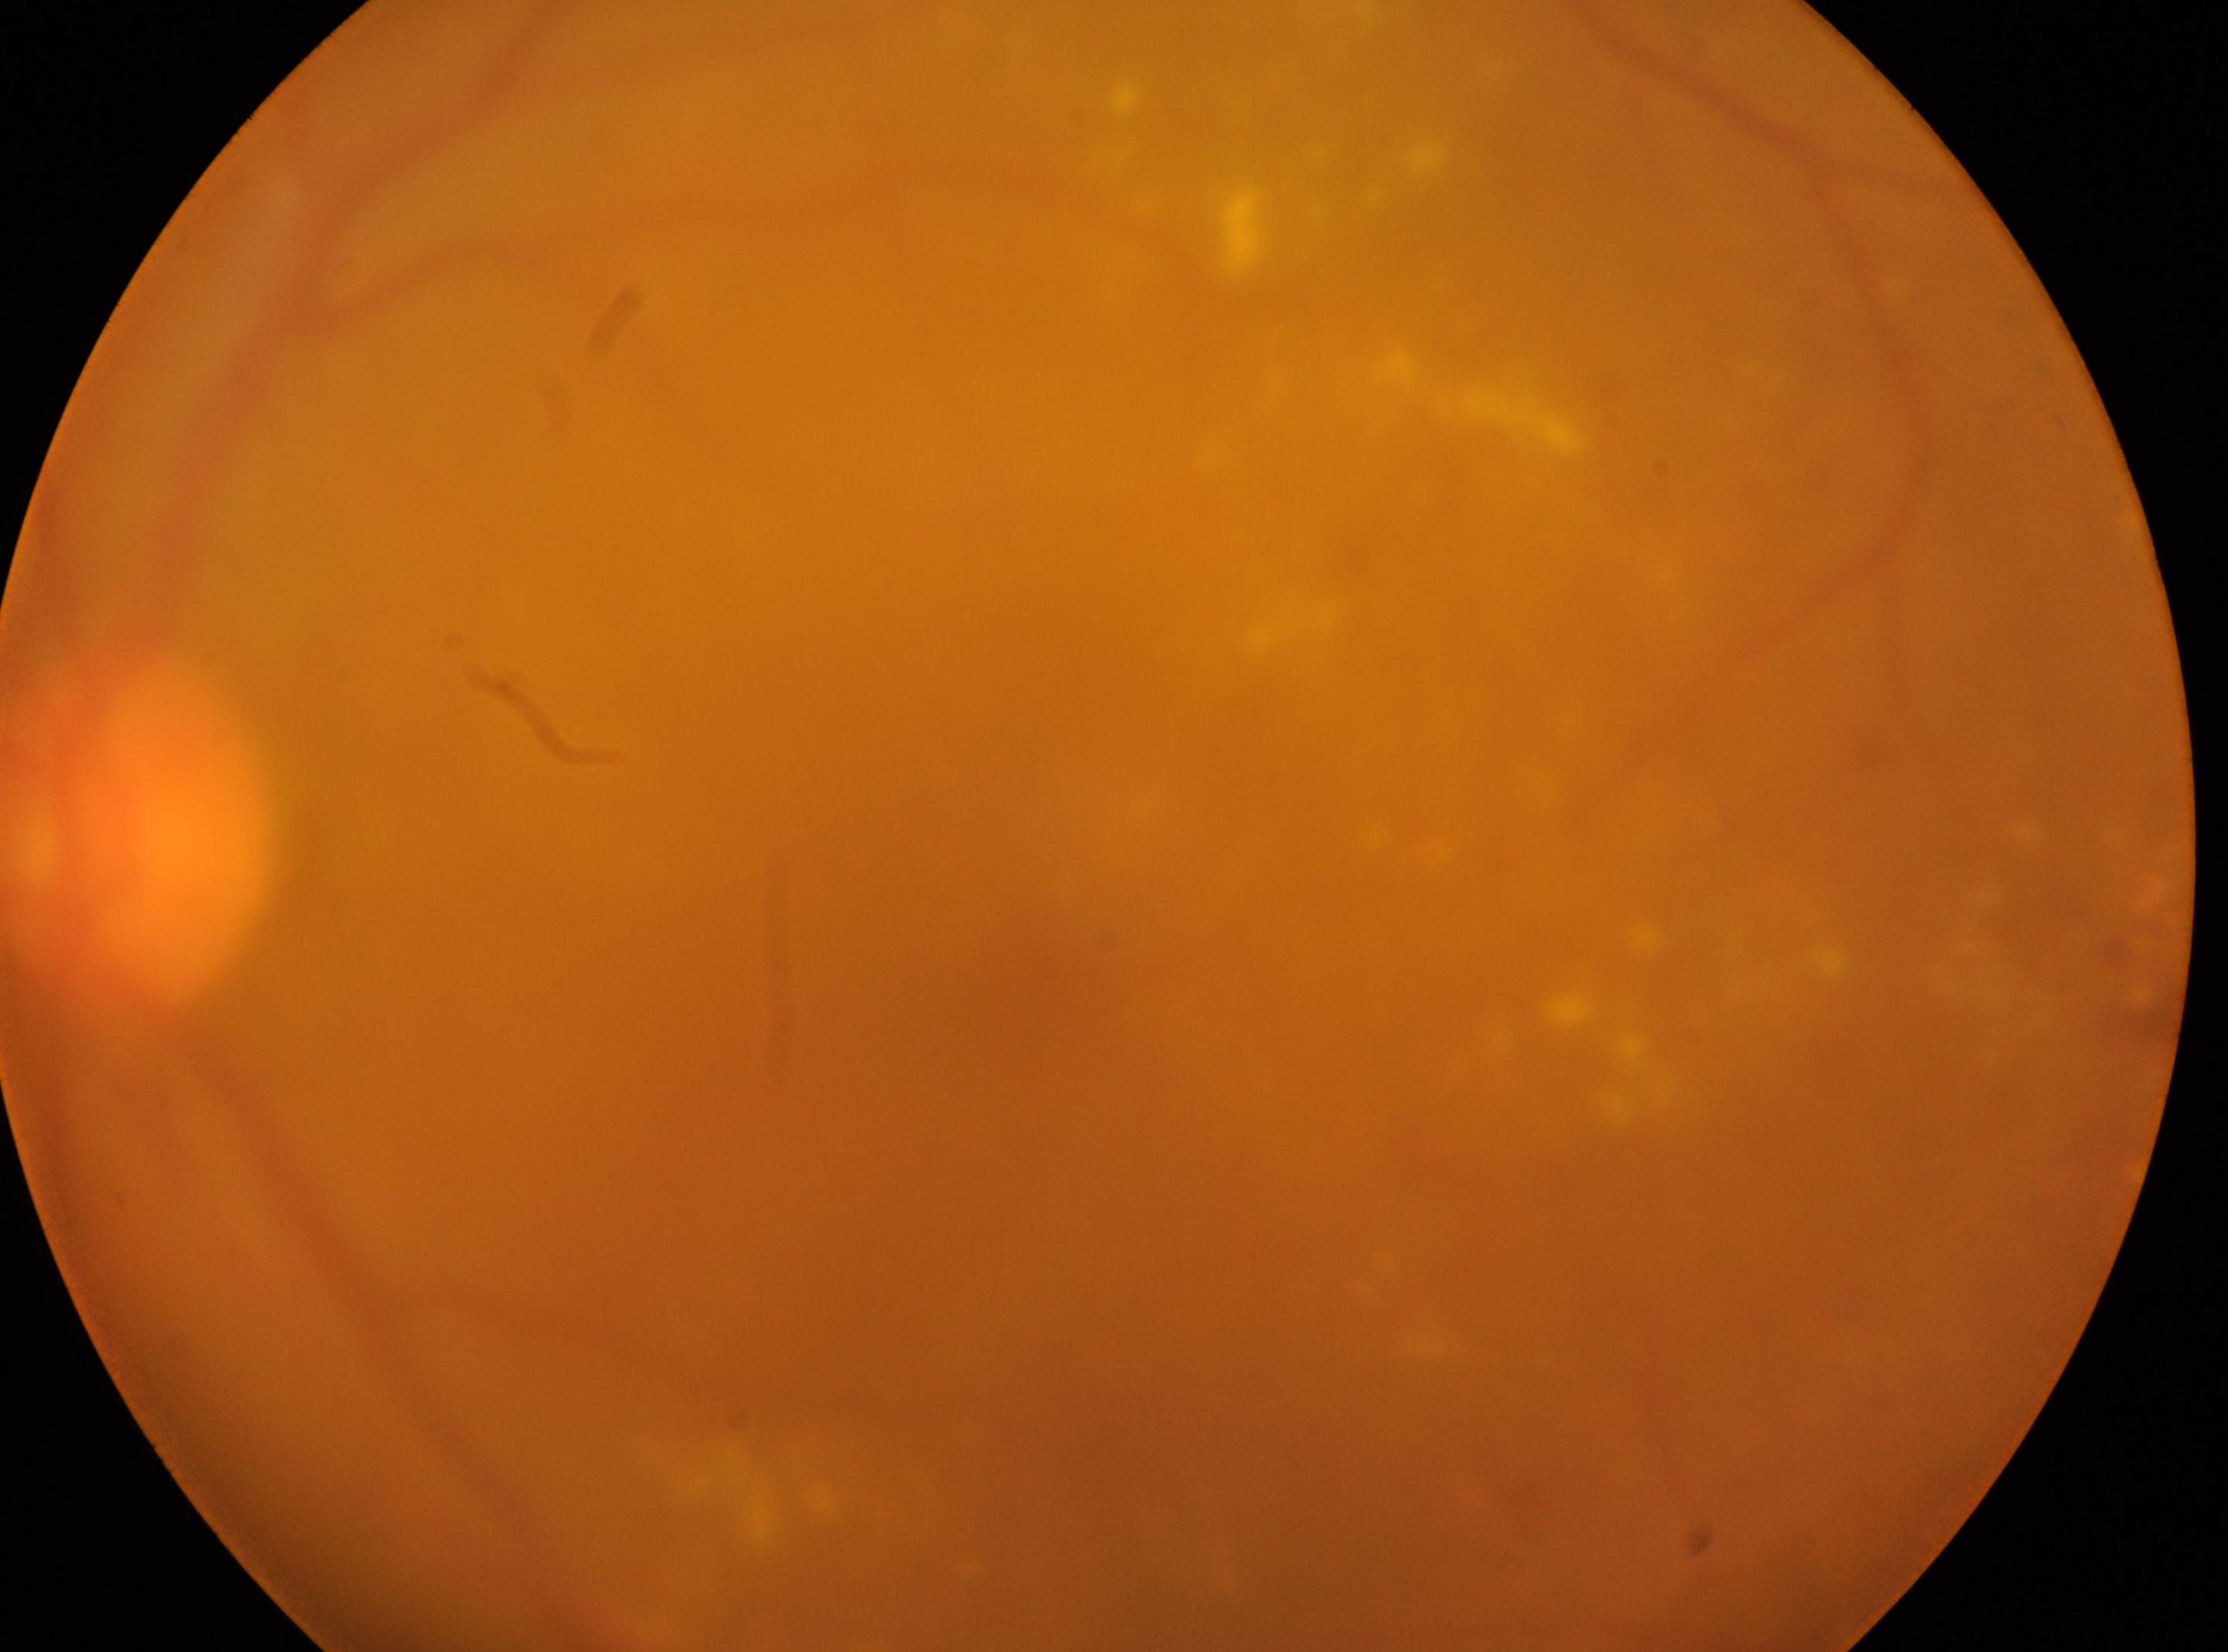

DR severity@2
left eye
macula center@x=1038, y=998
ONH@x=142, y=829